Optic disc photograph; camera: Topcon TRC; cropped from a 35-degree field of view — 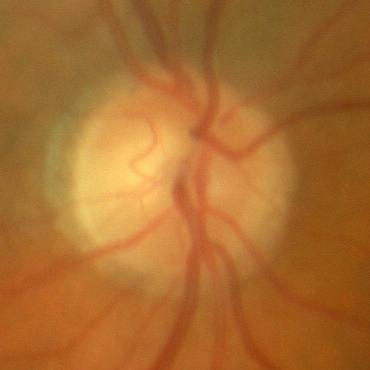 Glaucoma assessment = no glaucoma.